Clarity RetCam 3, 130° FOV · 640x480px · infant wide-field retinal image: 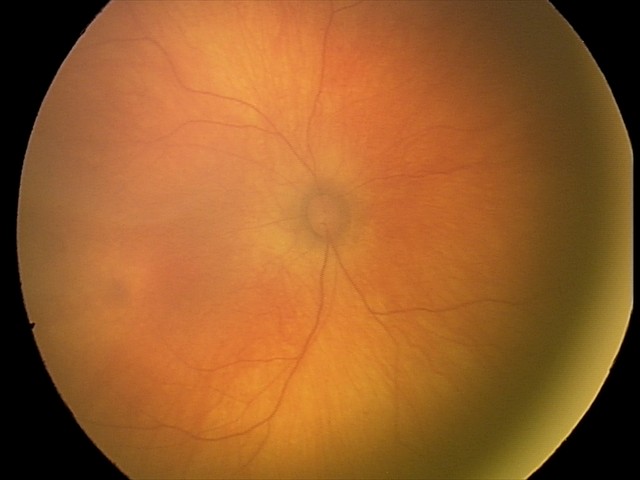
Normal screening examination.